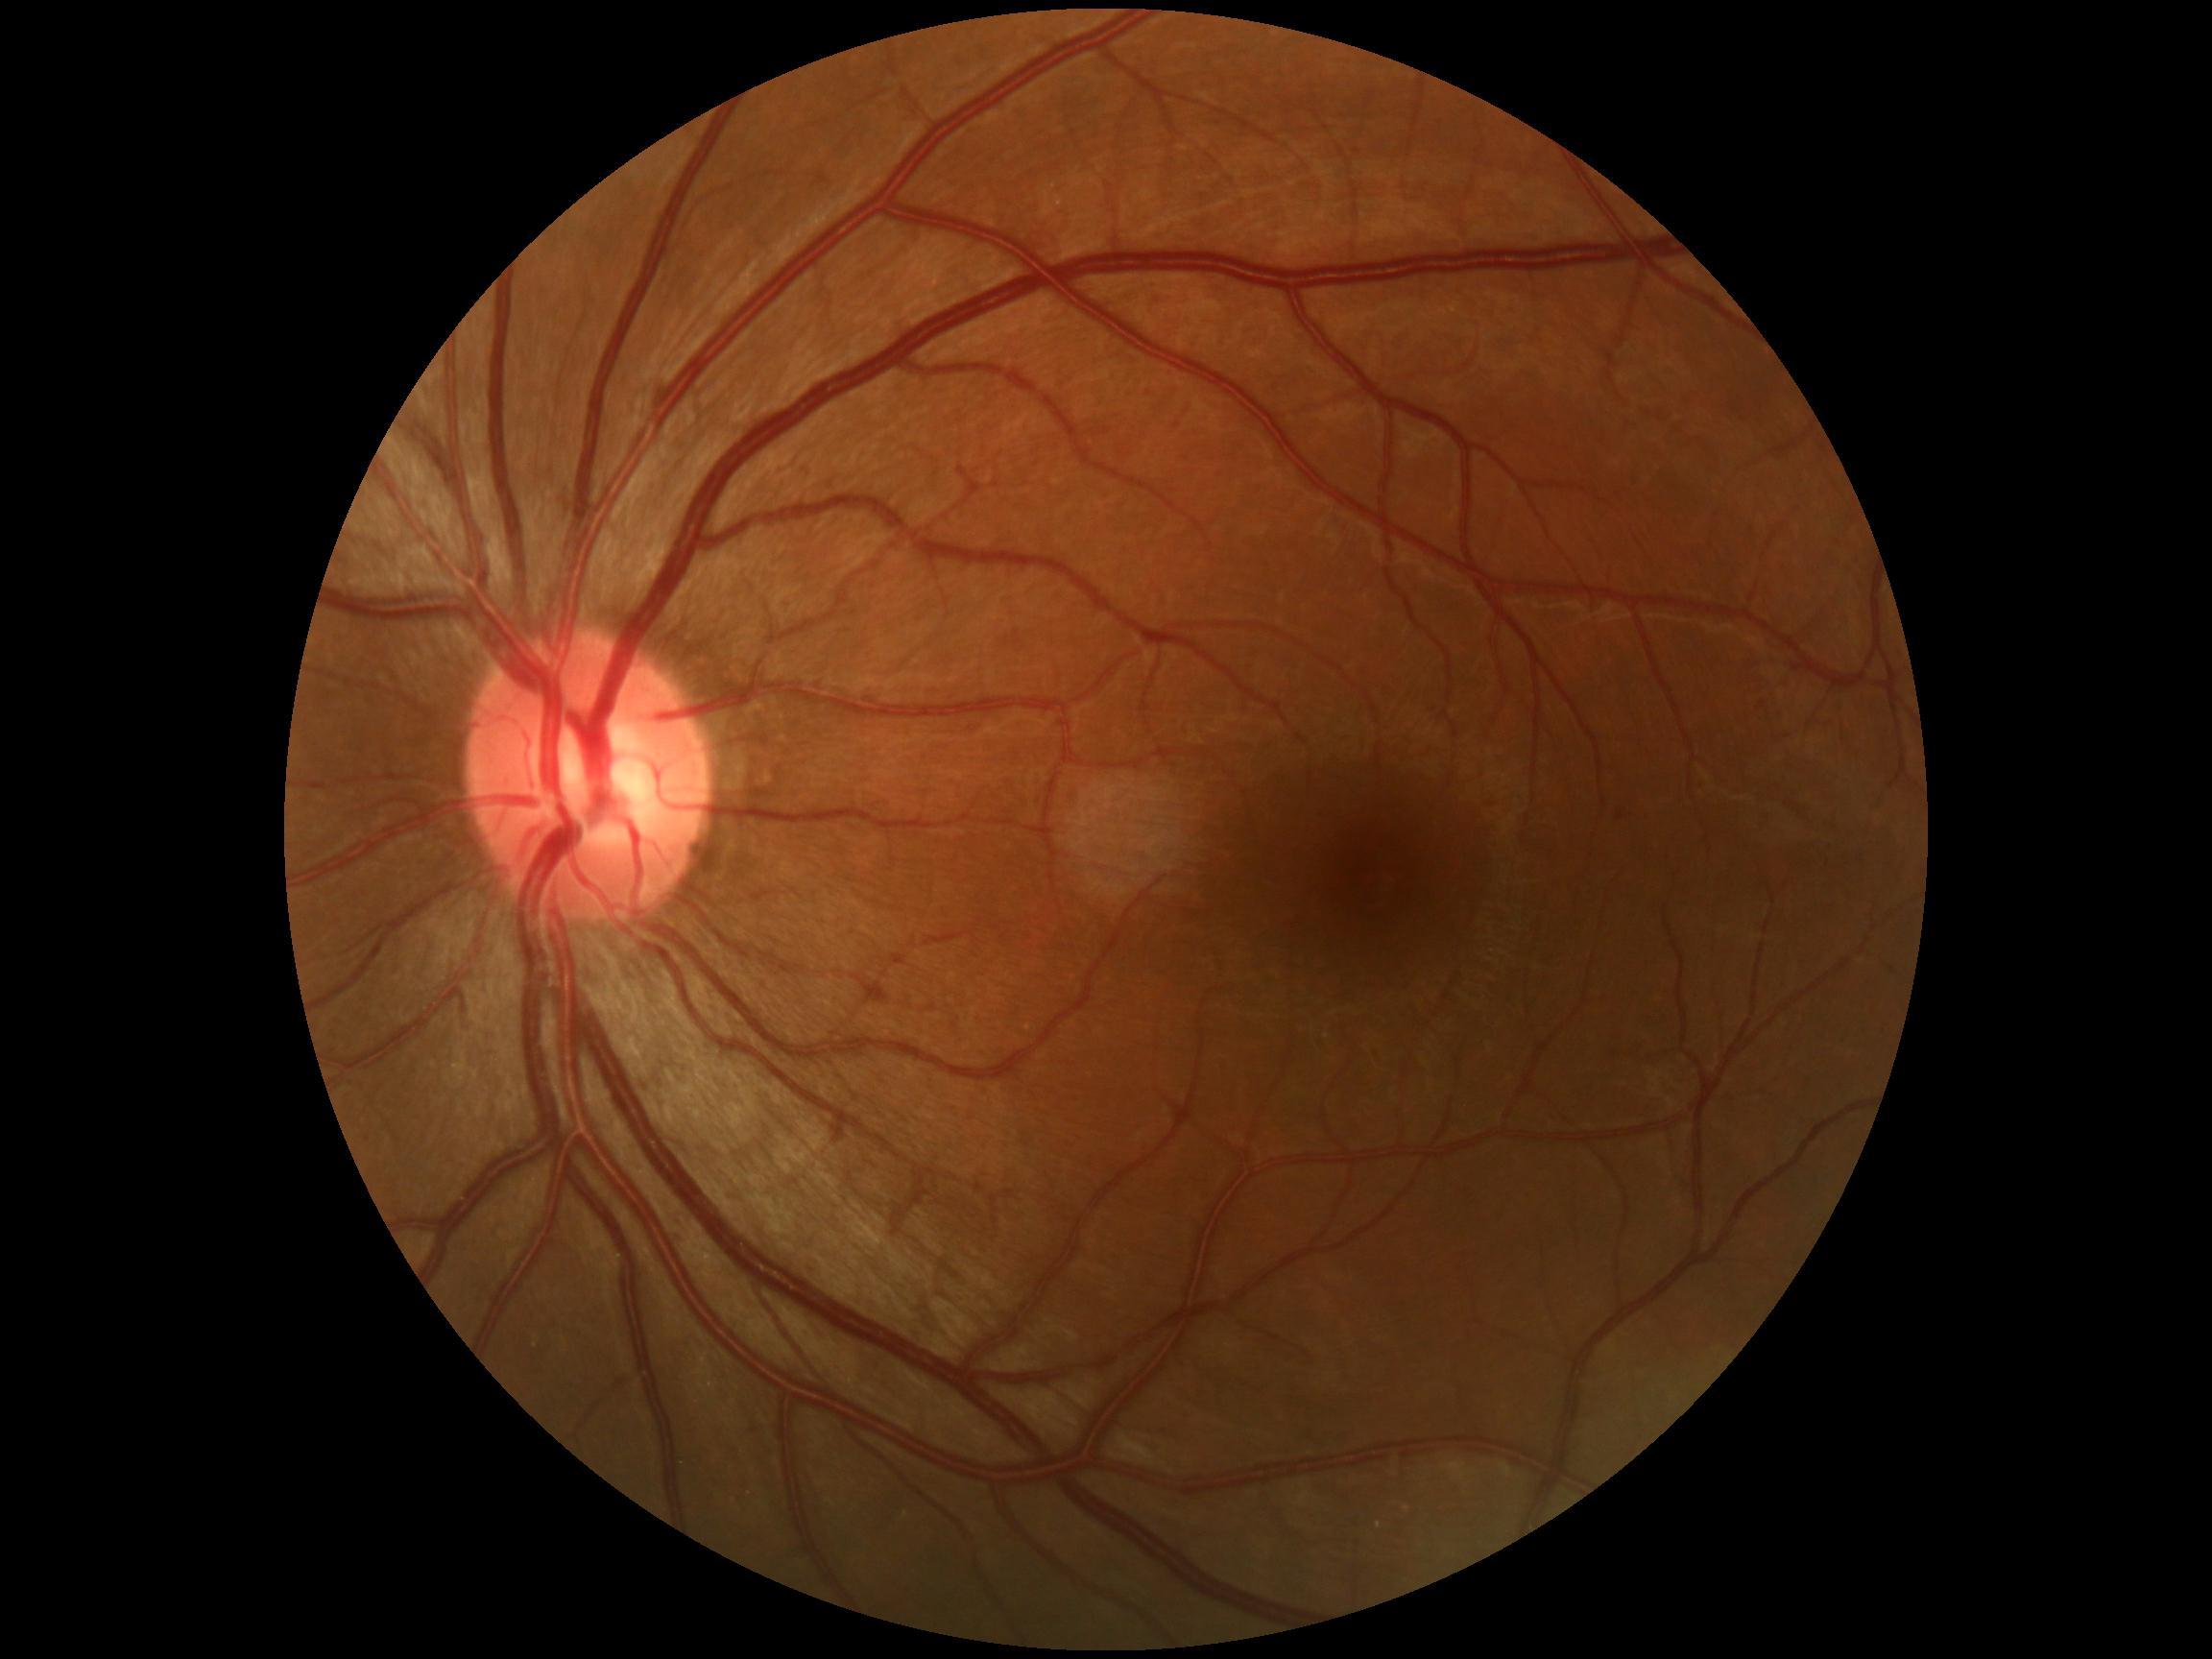

DR grade is mild NPDR (1)
• SEs: absent
• HEs: absent
• EXs: absent
• MAs: 1617,811,1624,821